Color fundus photograph, 2212x1659px:
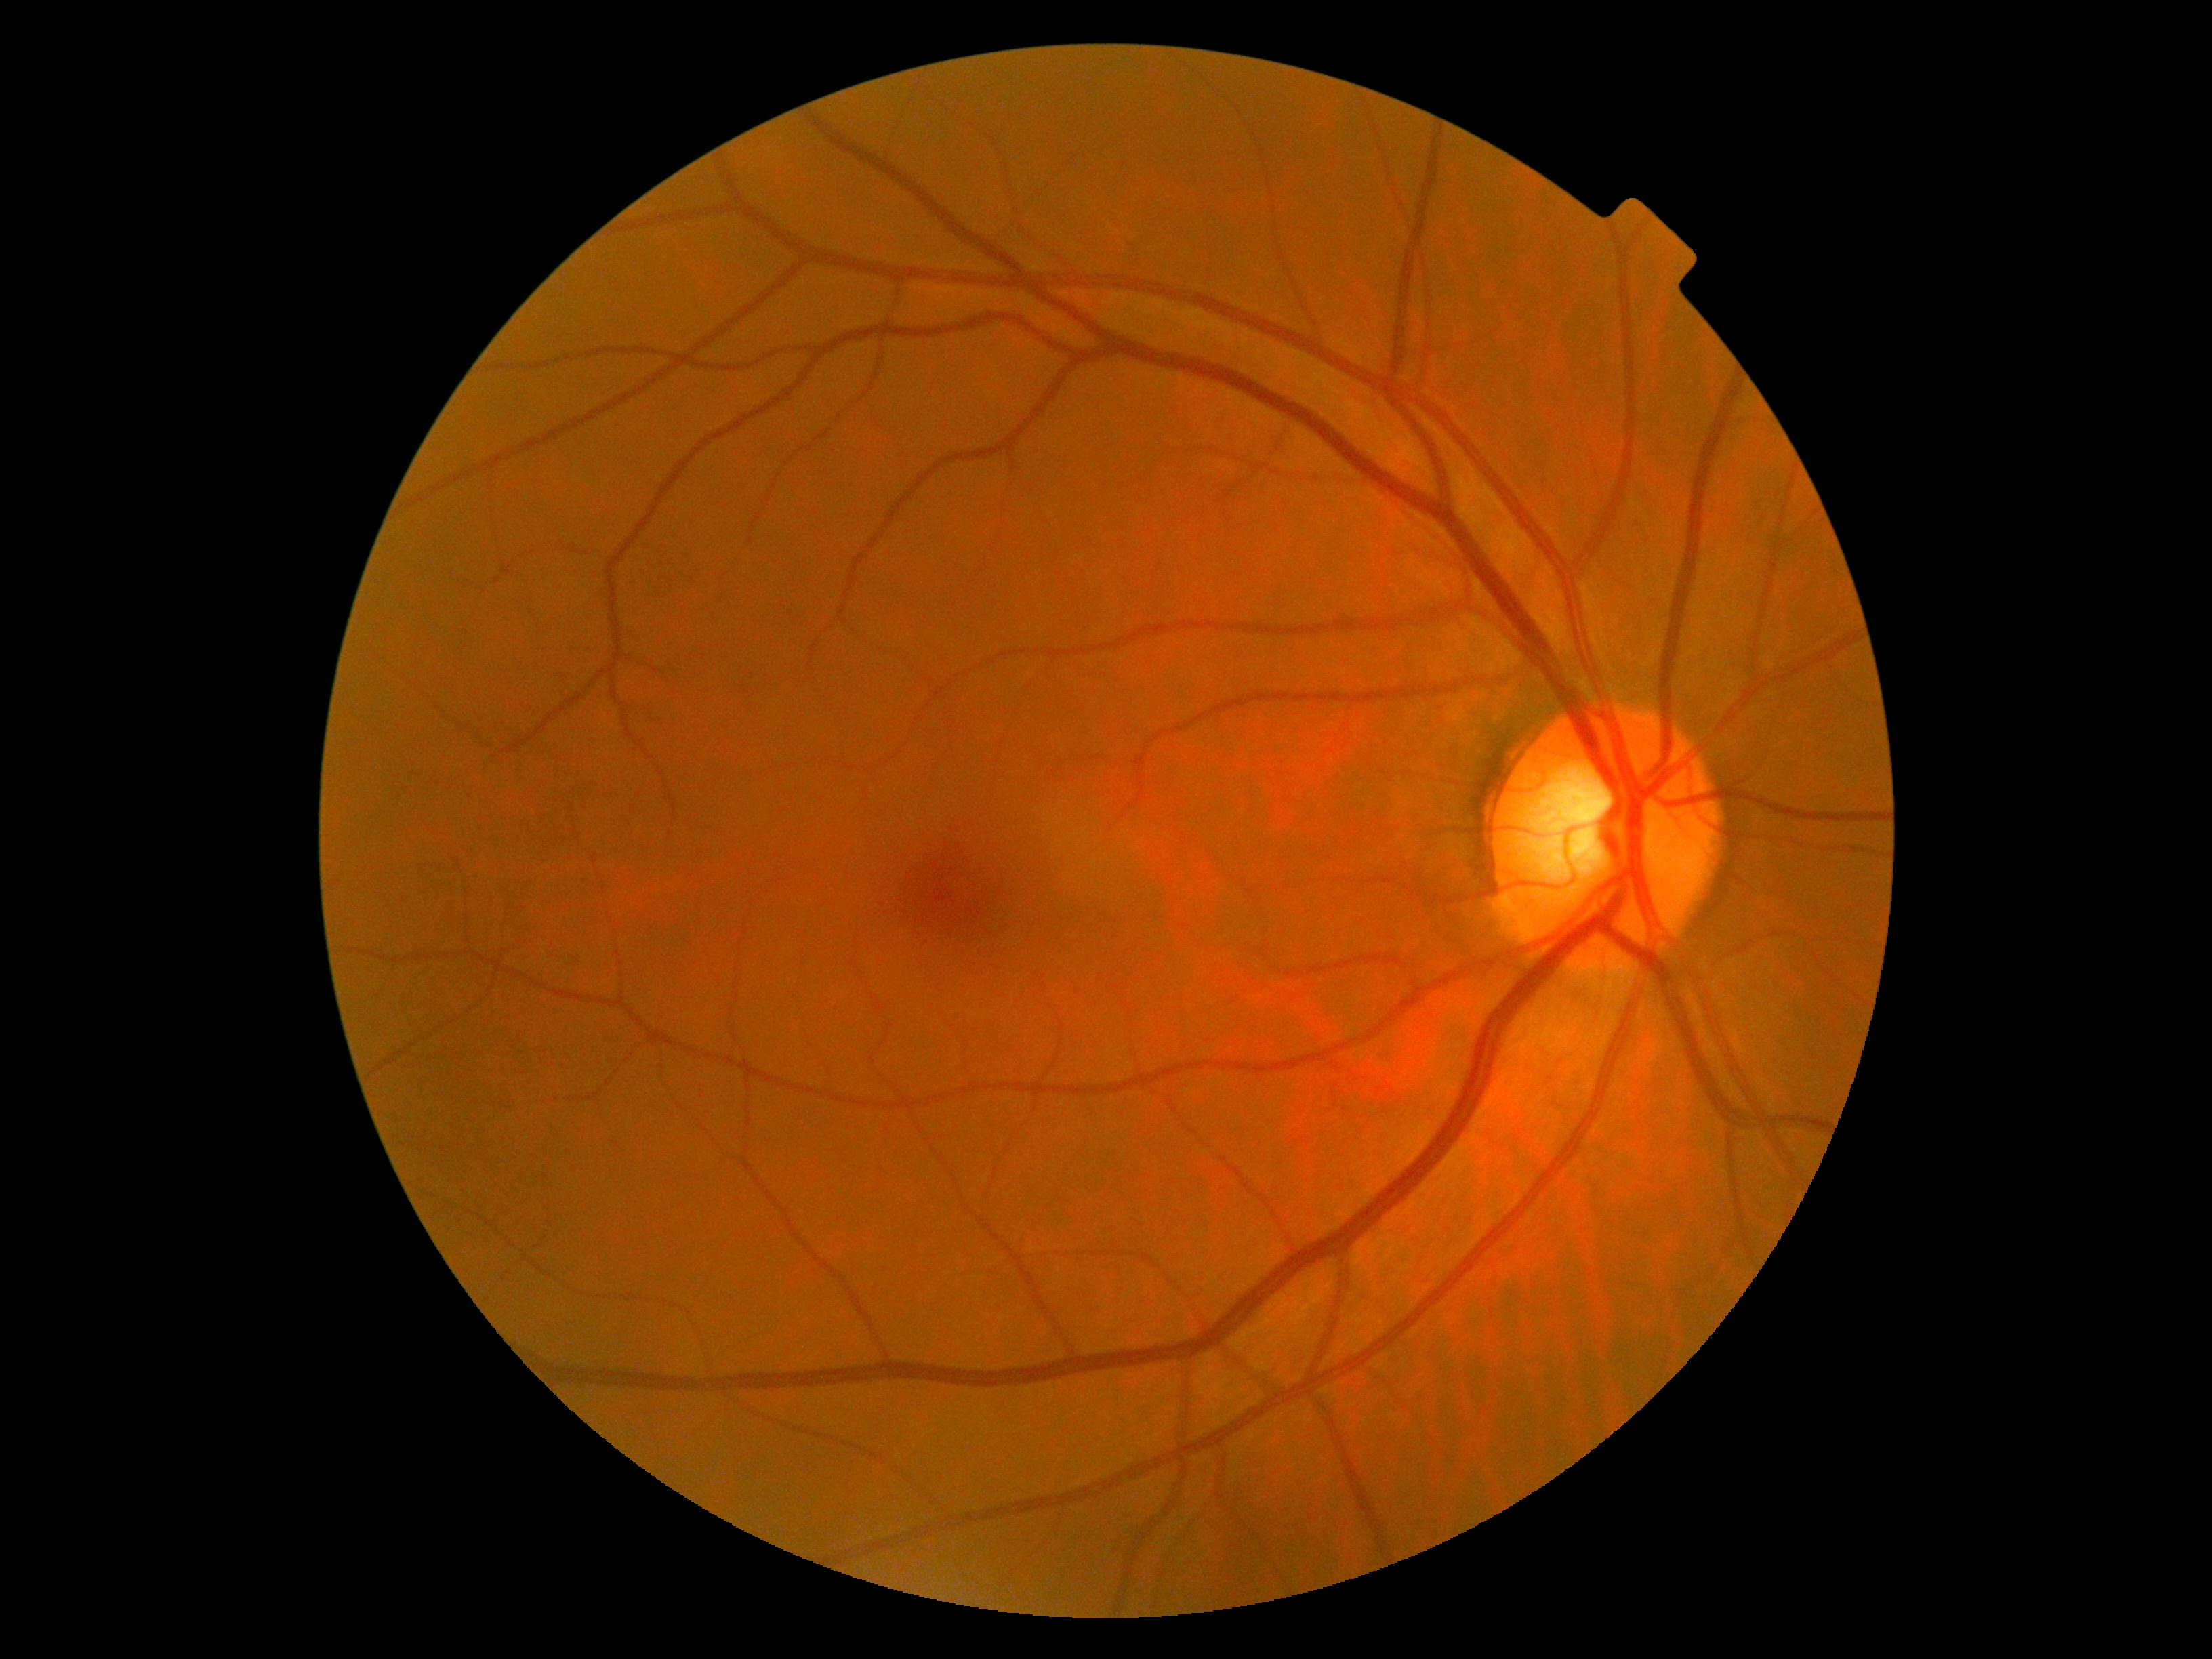

Diabetic retinopathy (DR) is grade 0 (no apparent retinopathy).